CFP; 848 x 848 pixels; nonmydriatic; NIDEK AFC-230 fundus camera: 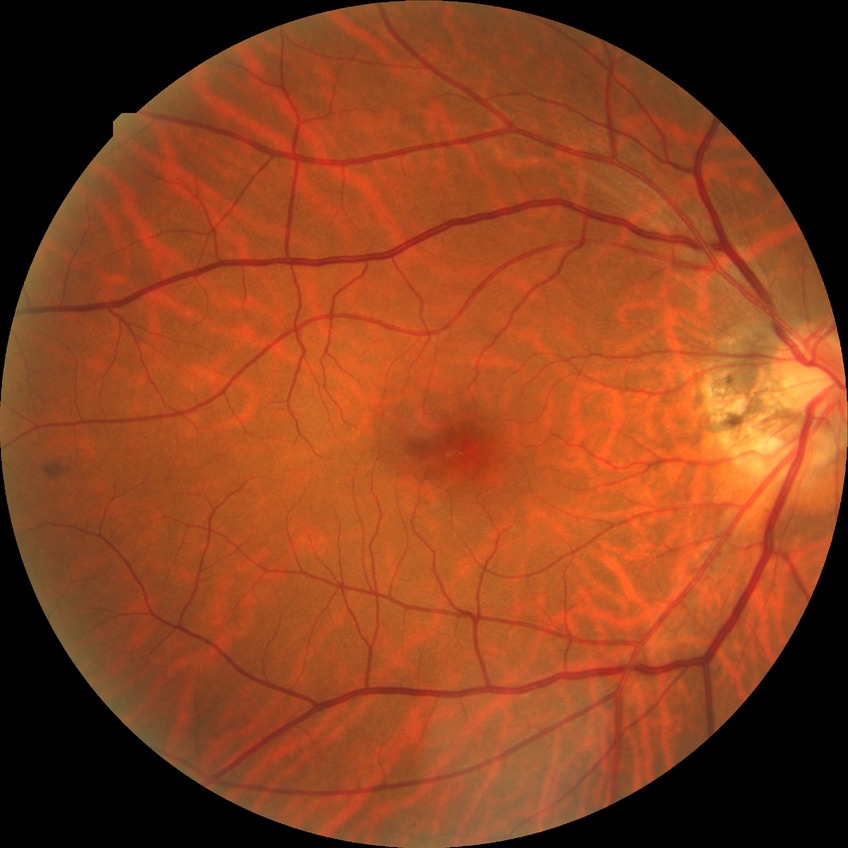

diabetic retinopathy (DR)@NDR (no diabetic retinopathy).